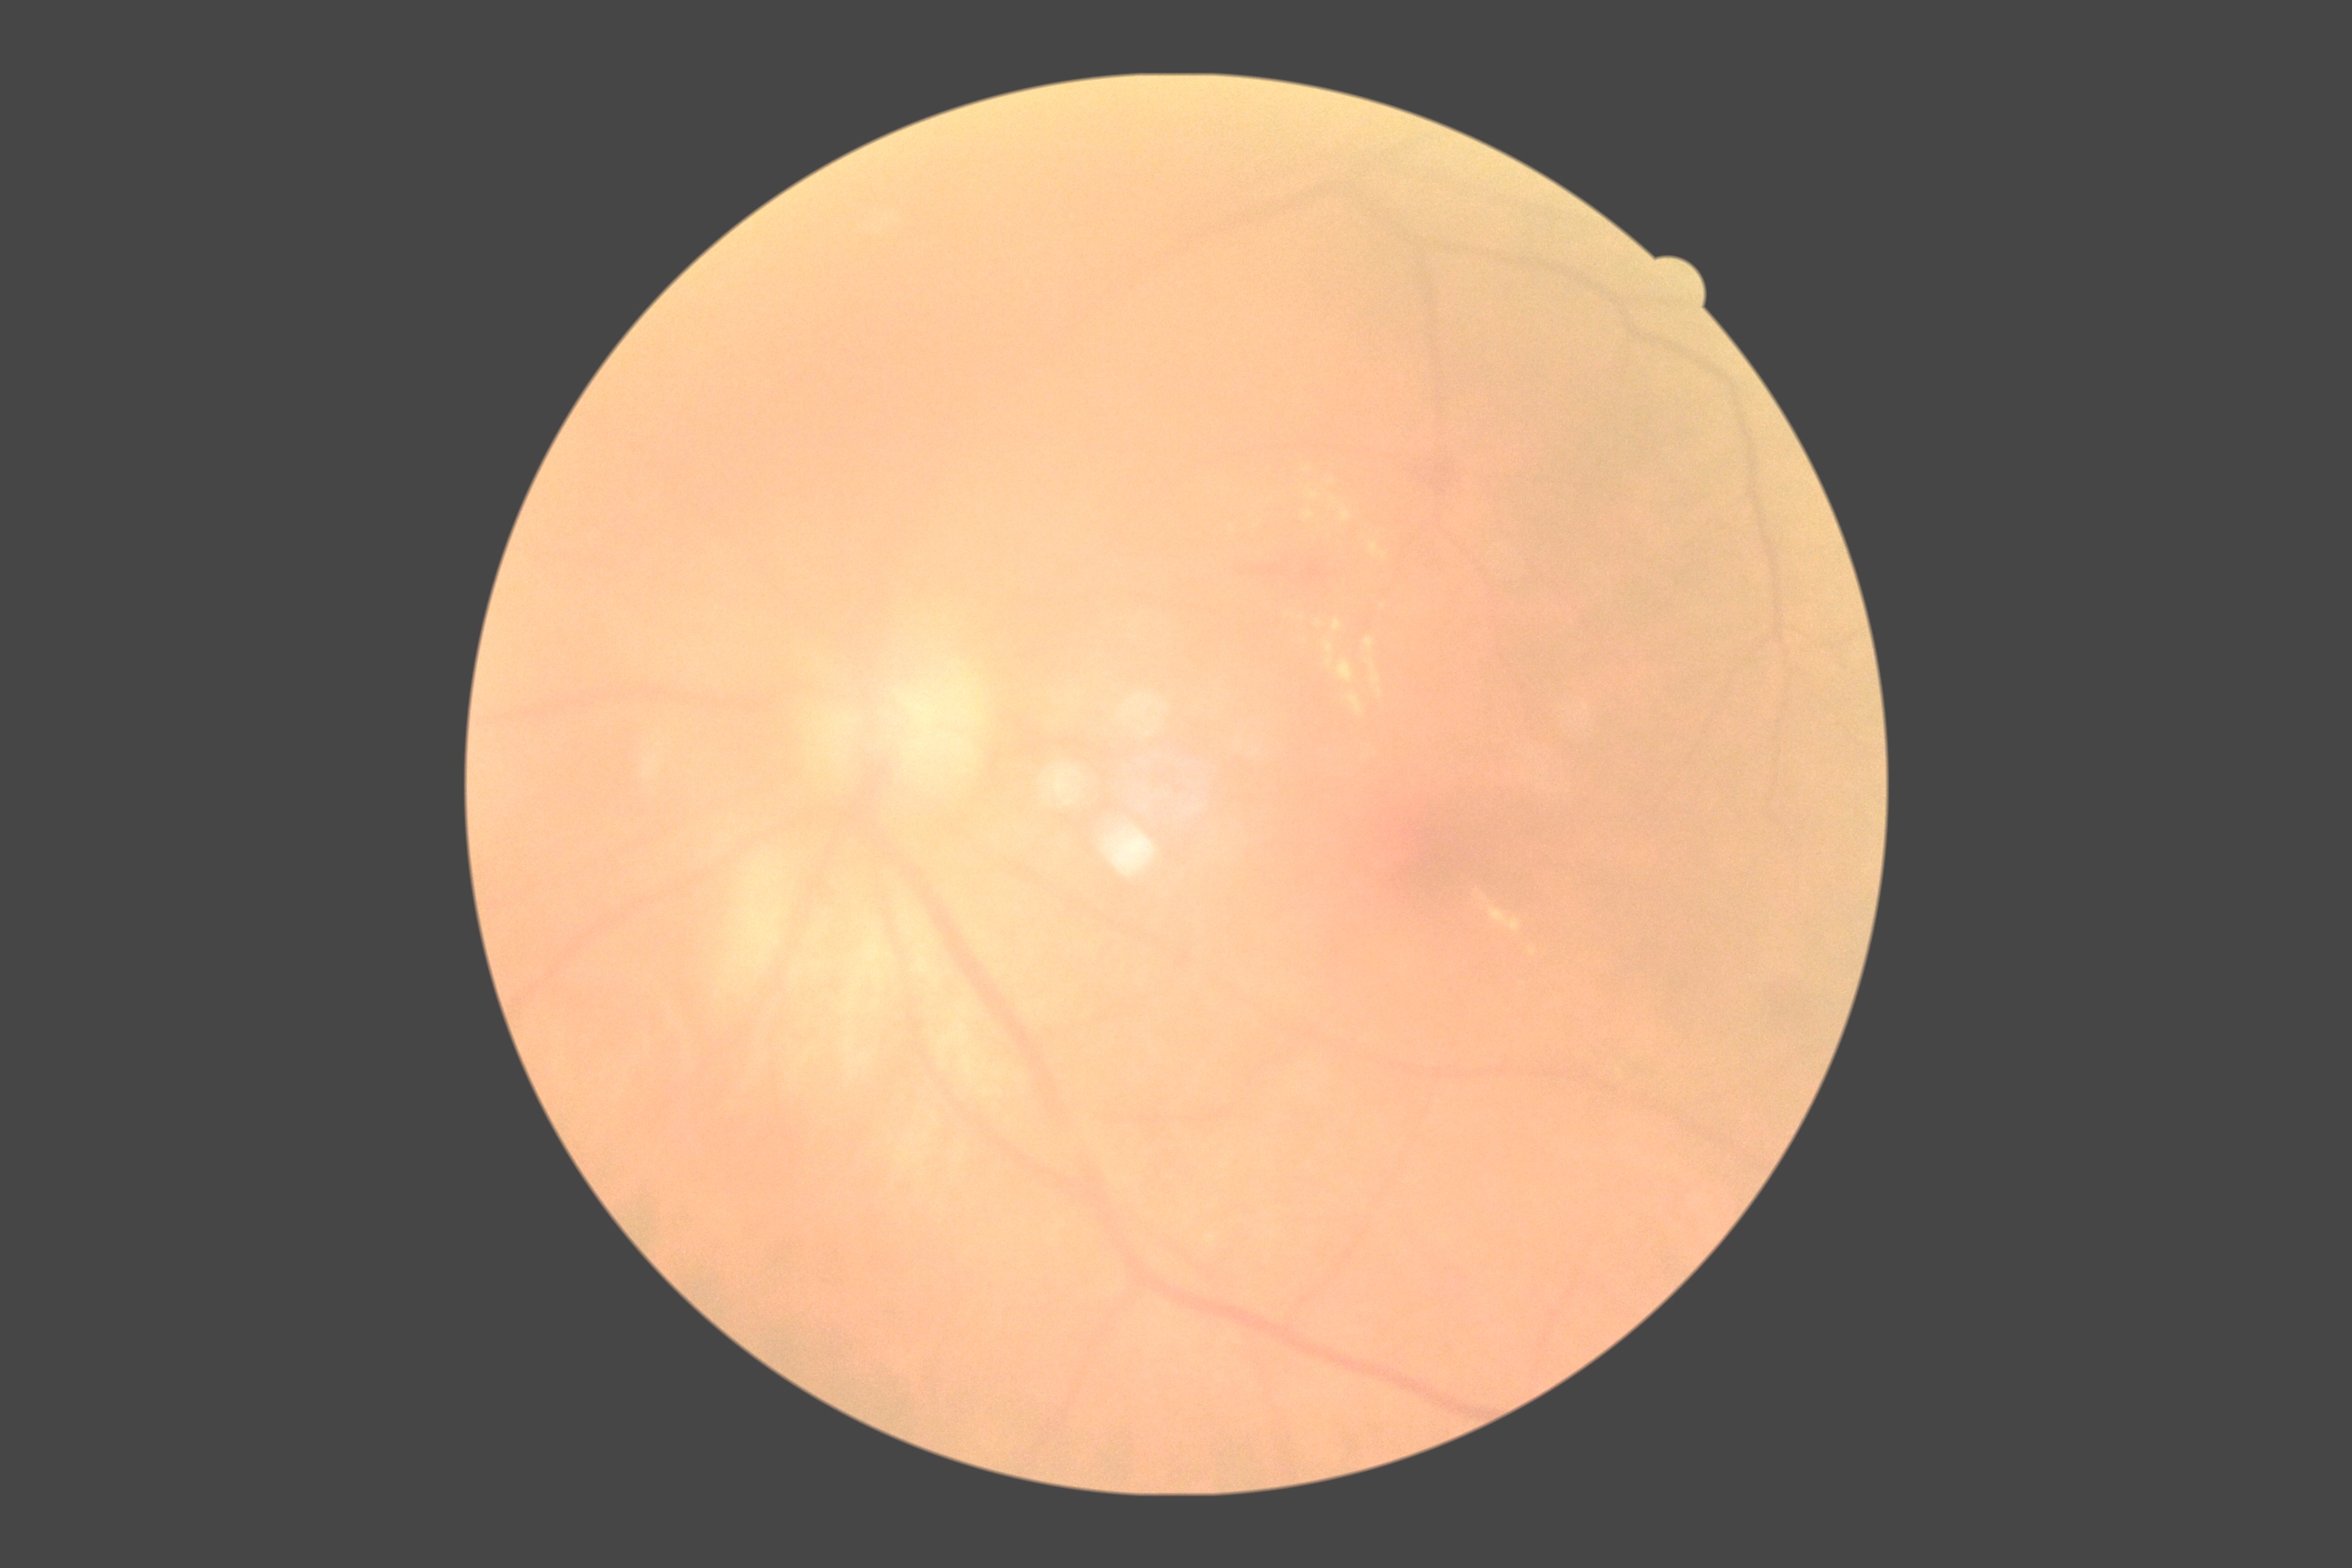

DR: grade 2 (moderate NPDR).